CFP, FOV: 45 degrees: 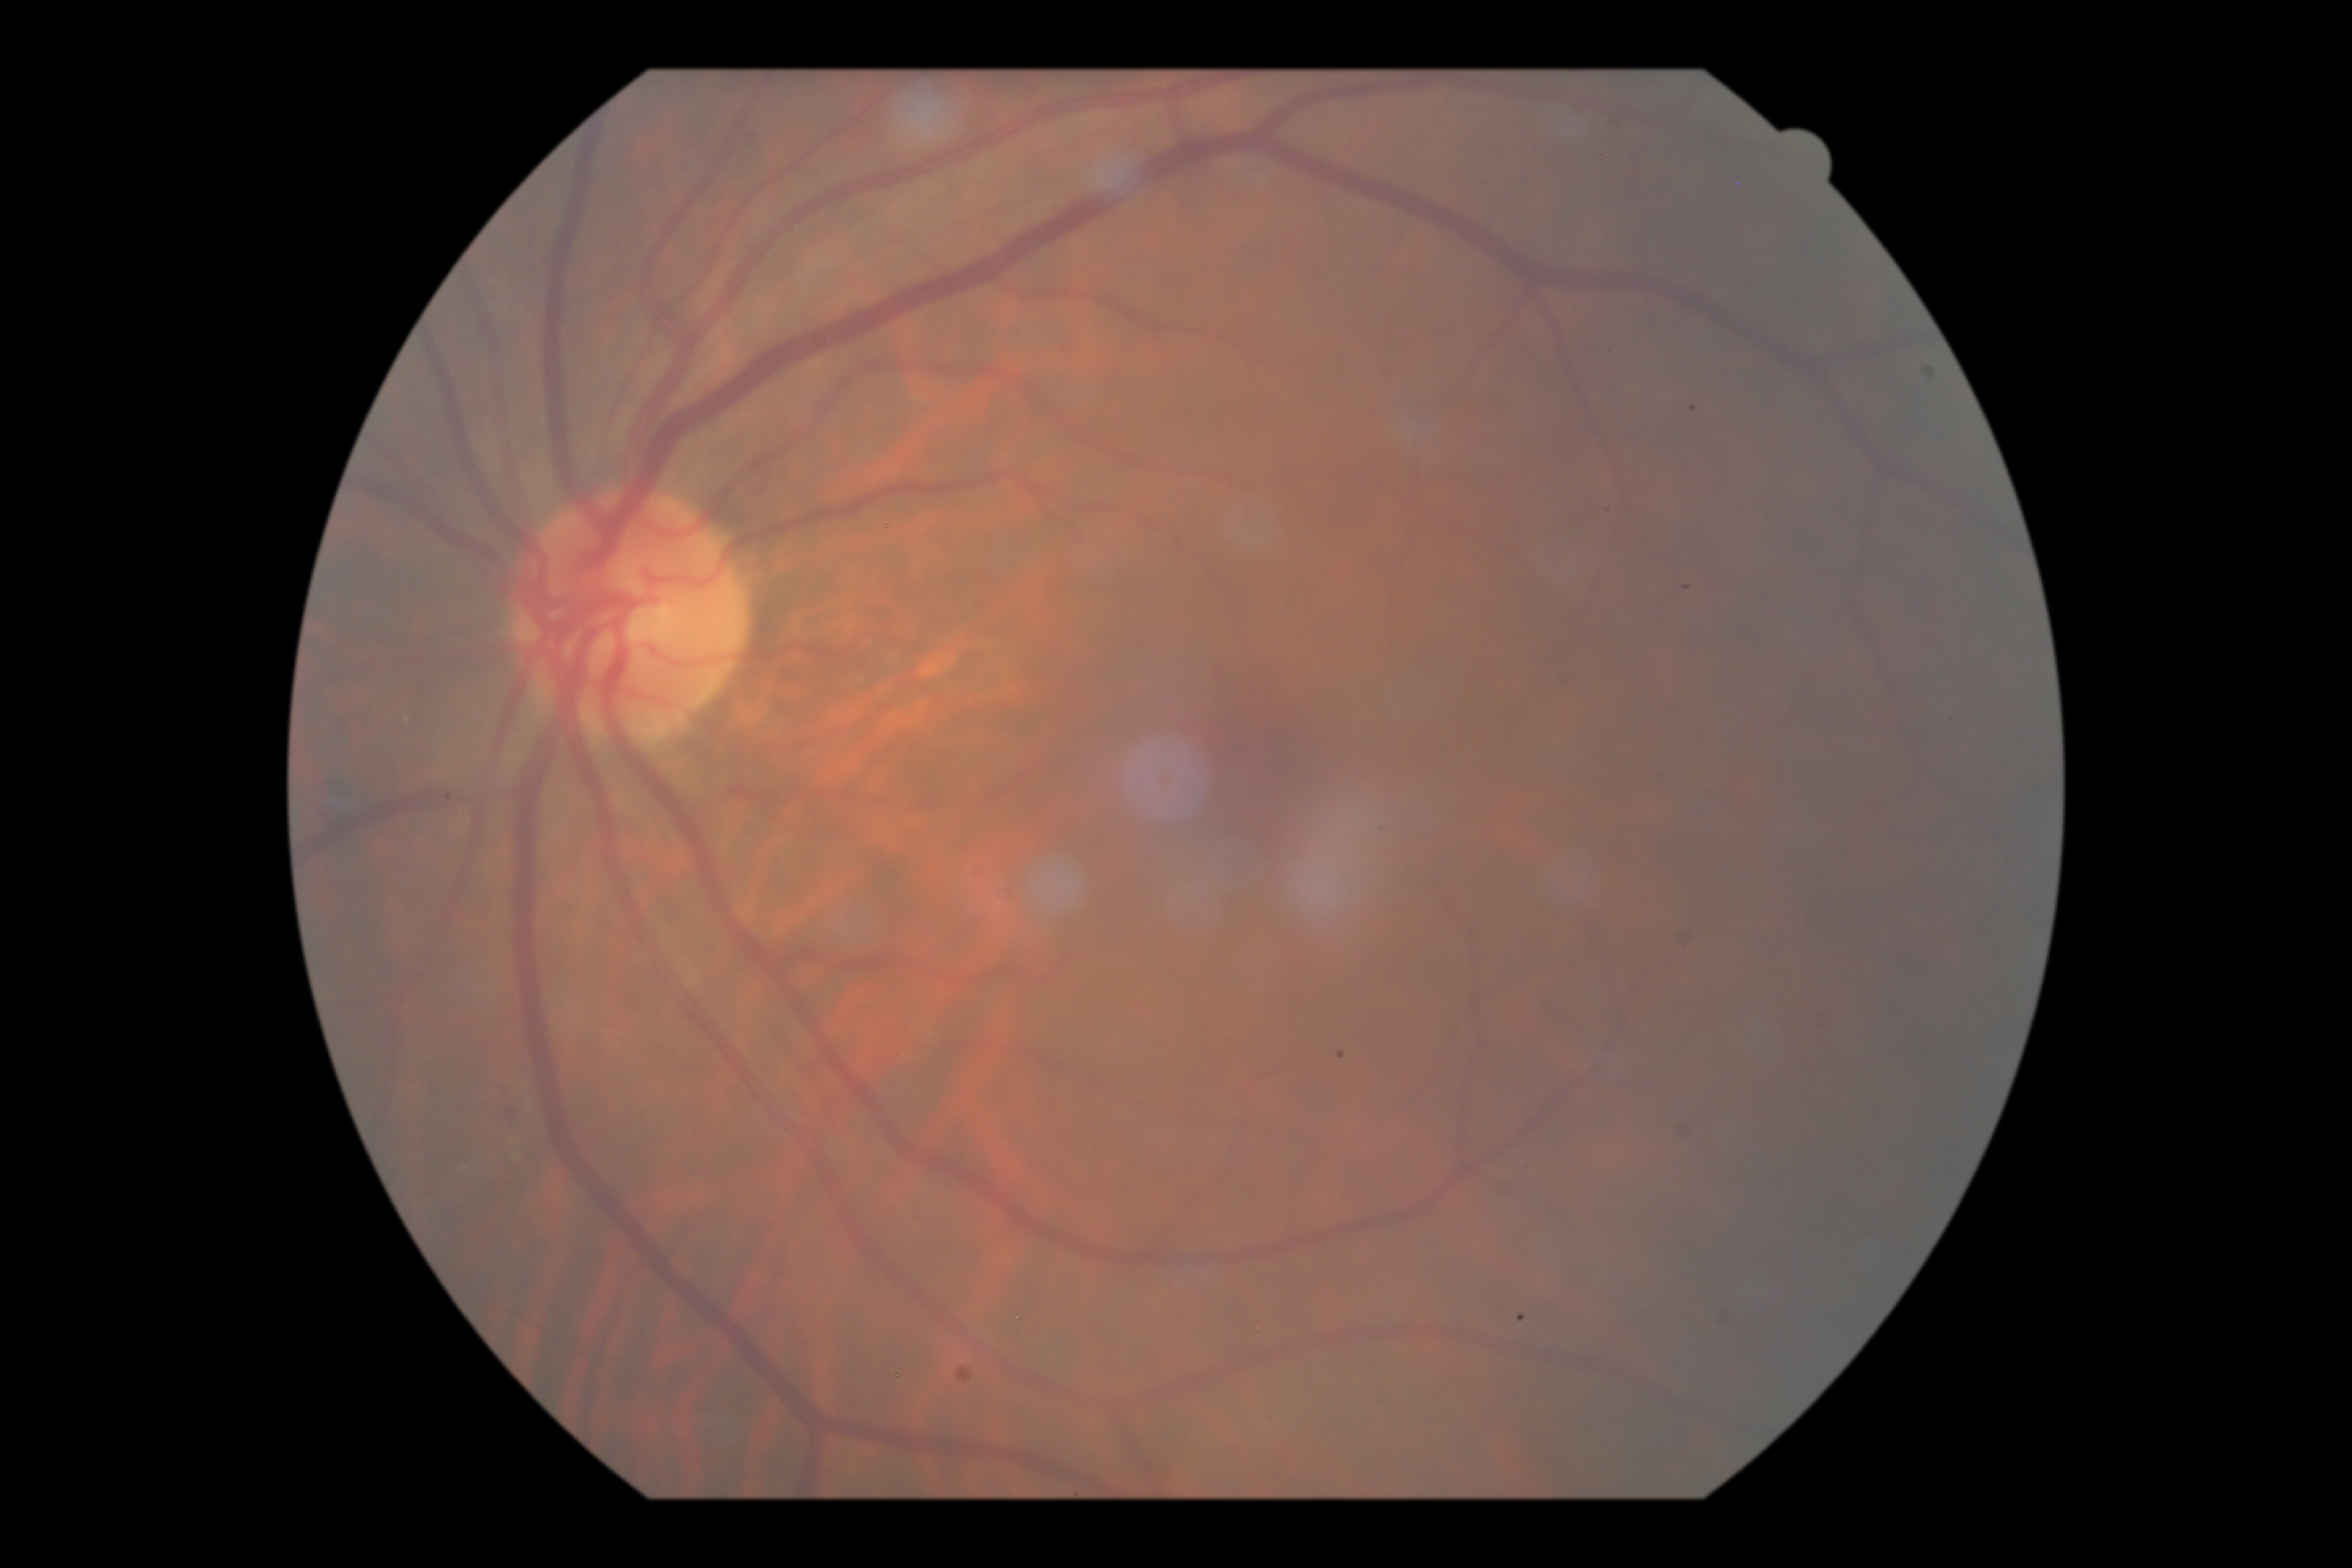 Diabetic retinopathy (DR): 0 — no visible signs of diabetic retinopathy. No apparent diabetic retinopathy.